CFP
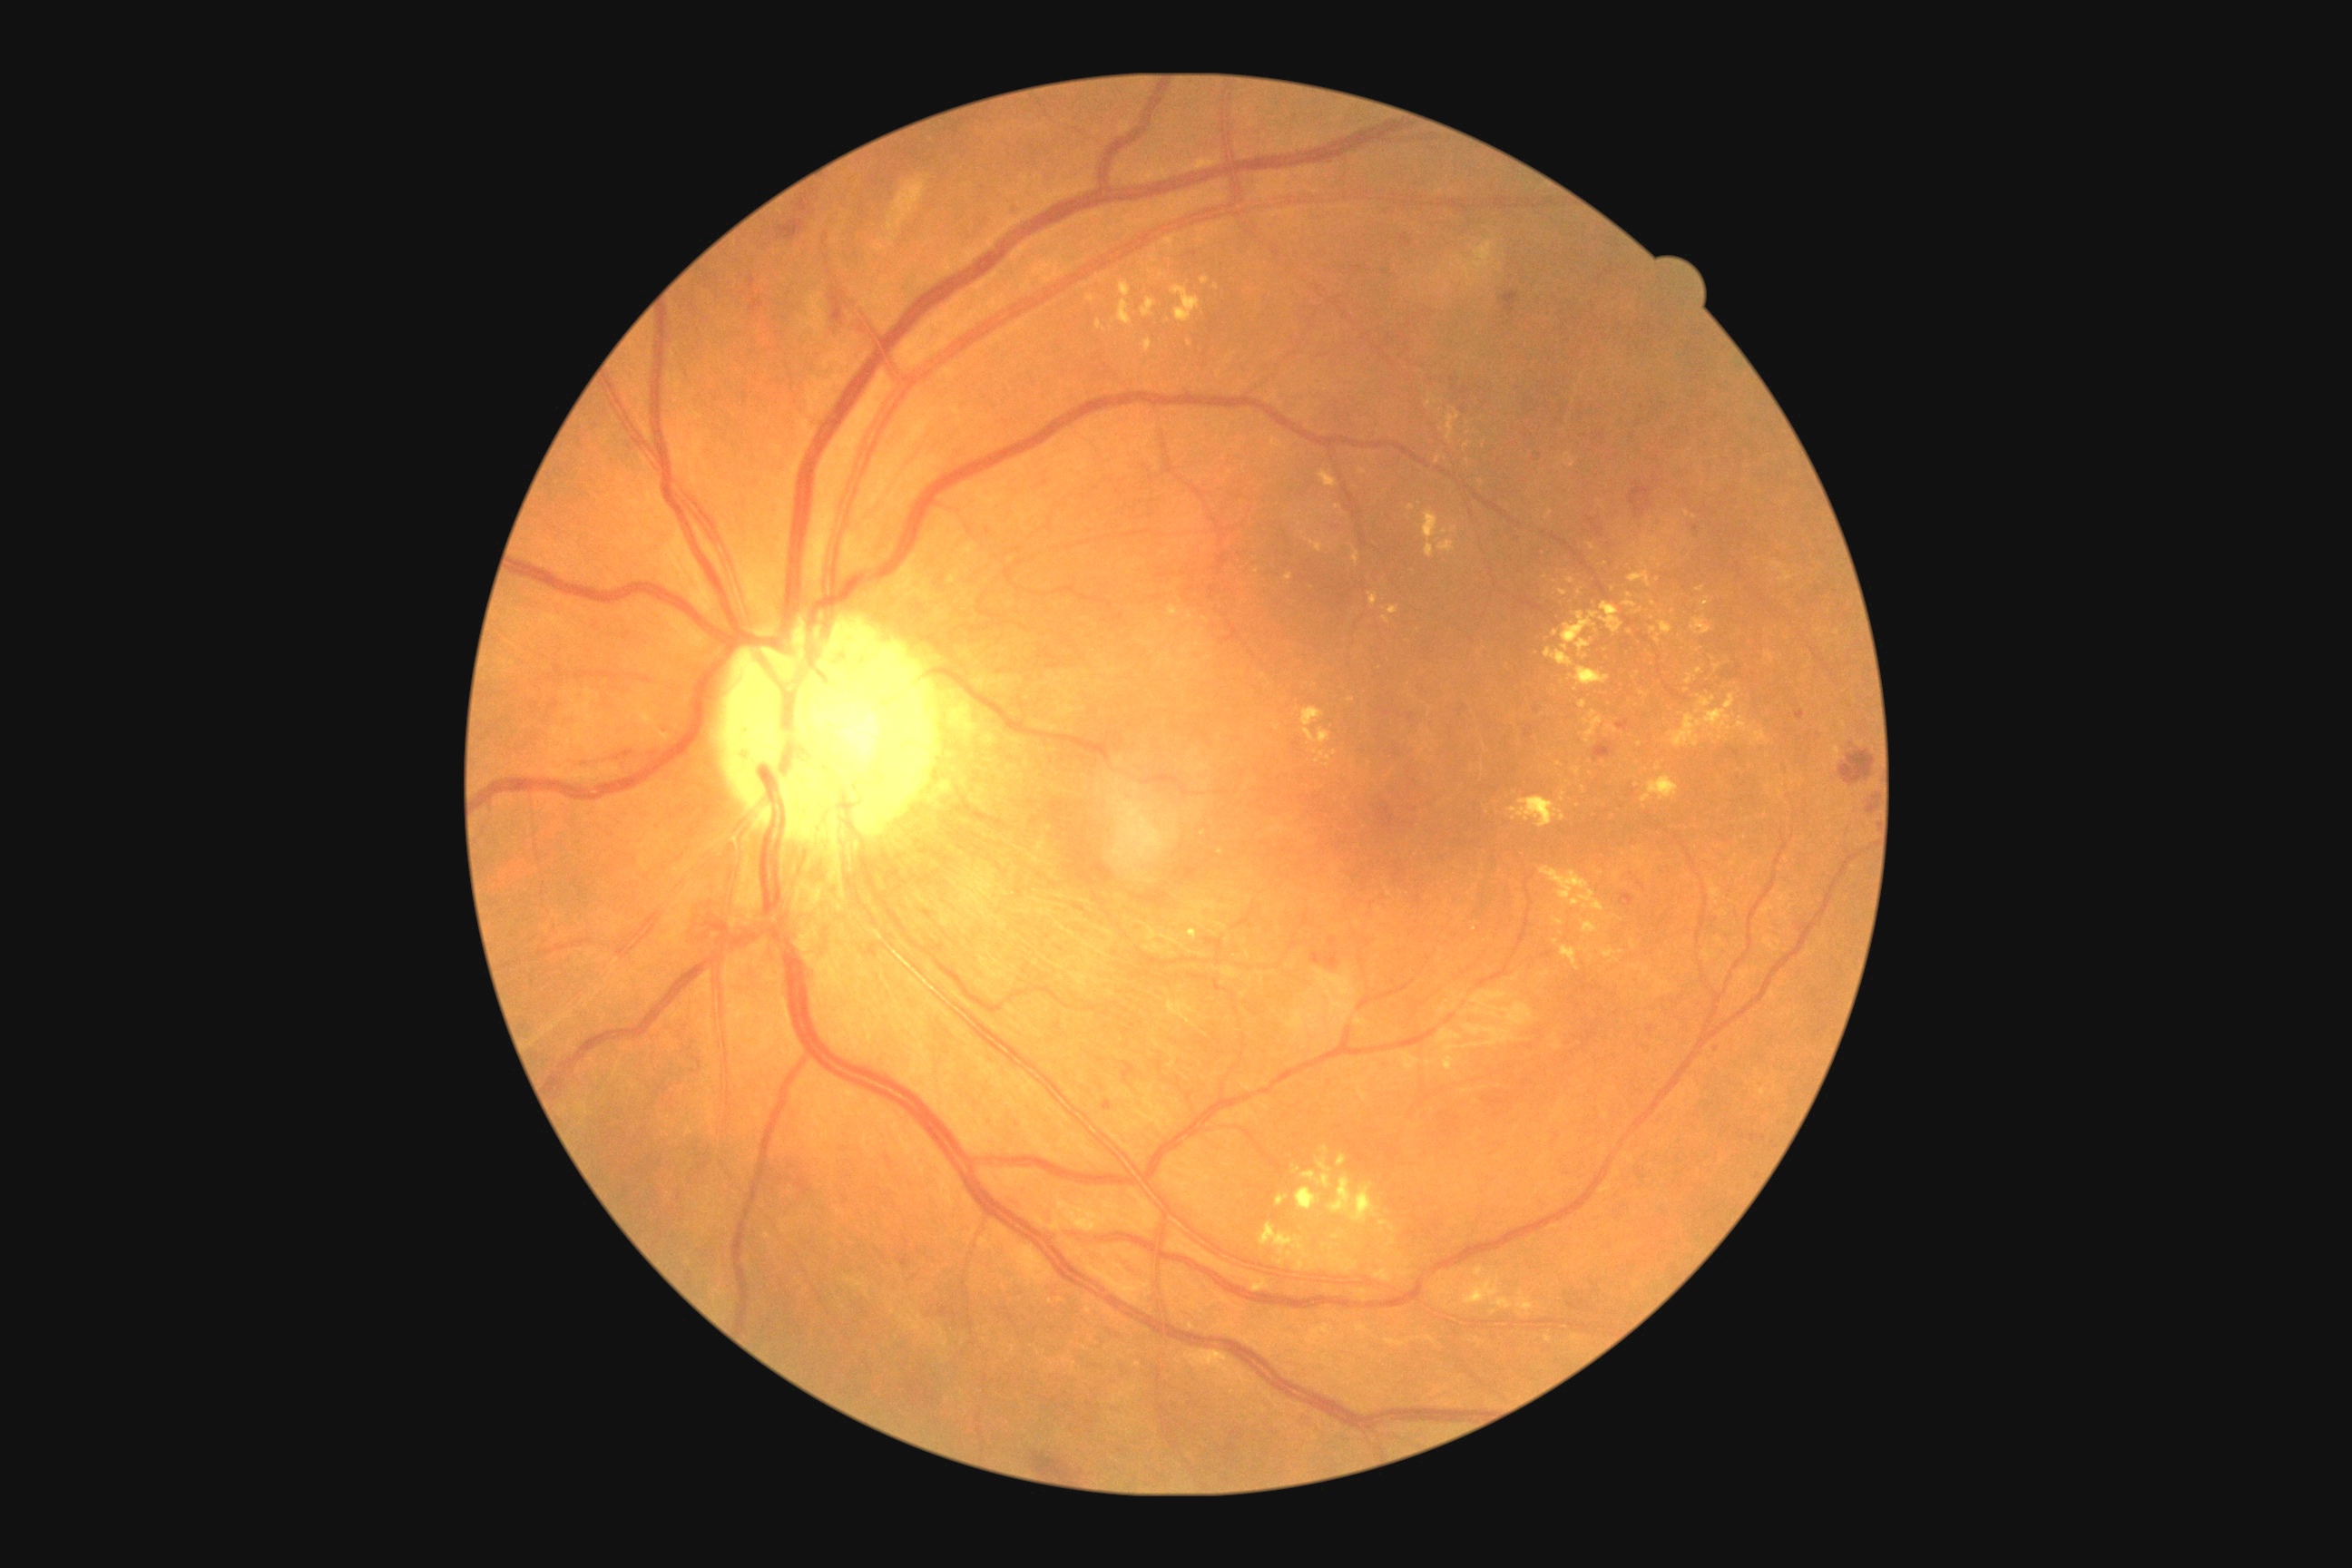 {"partial": true, "dr_grade": 2, "dr_grade_name": "moderate NPDR", "lesions": {"ex": [[1634, 672, 1640, 680], [1551, 917, 1563, 926], [1765, 652, 1774, 663], [1142, 340, 1153, 353], [1545, 511, 1553, 520], [1545, 612, 1600, 667], [1607, 727, 1618, 734], [1436, 456, 1442, 466], [1654, 977, 1672, 995], [1438, 540, 1455, 553], [1642, 776, 1678, 803], [1562, 946, 1580, 972]], "ex_small_centers": [[1297, 1171], [1315, 752], [1653, 604], [1768, 788], [1336, 1237], [1601, 874], [1276, 728], [1392, 1228]]}}